Tabletop color fundus camera image: 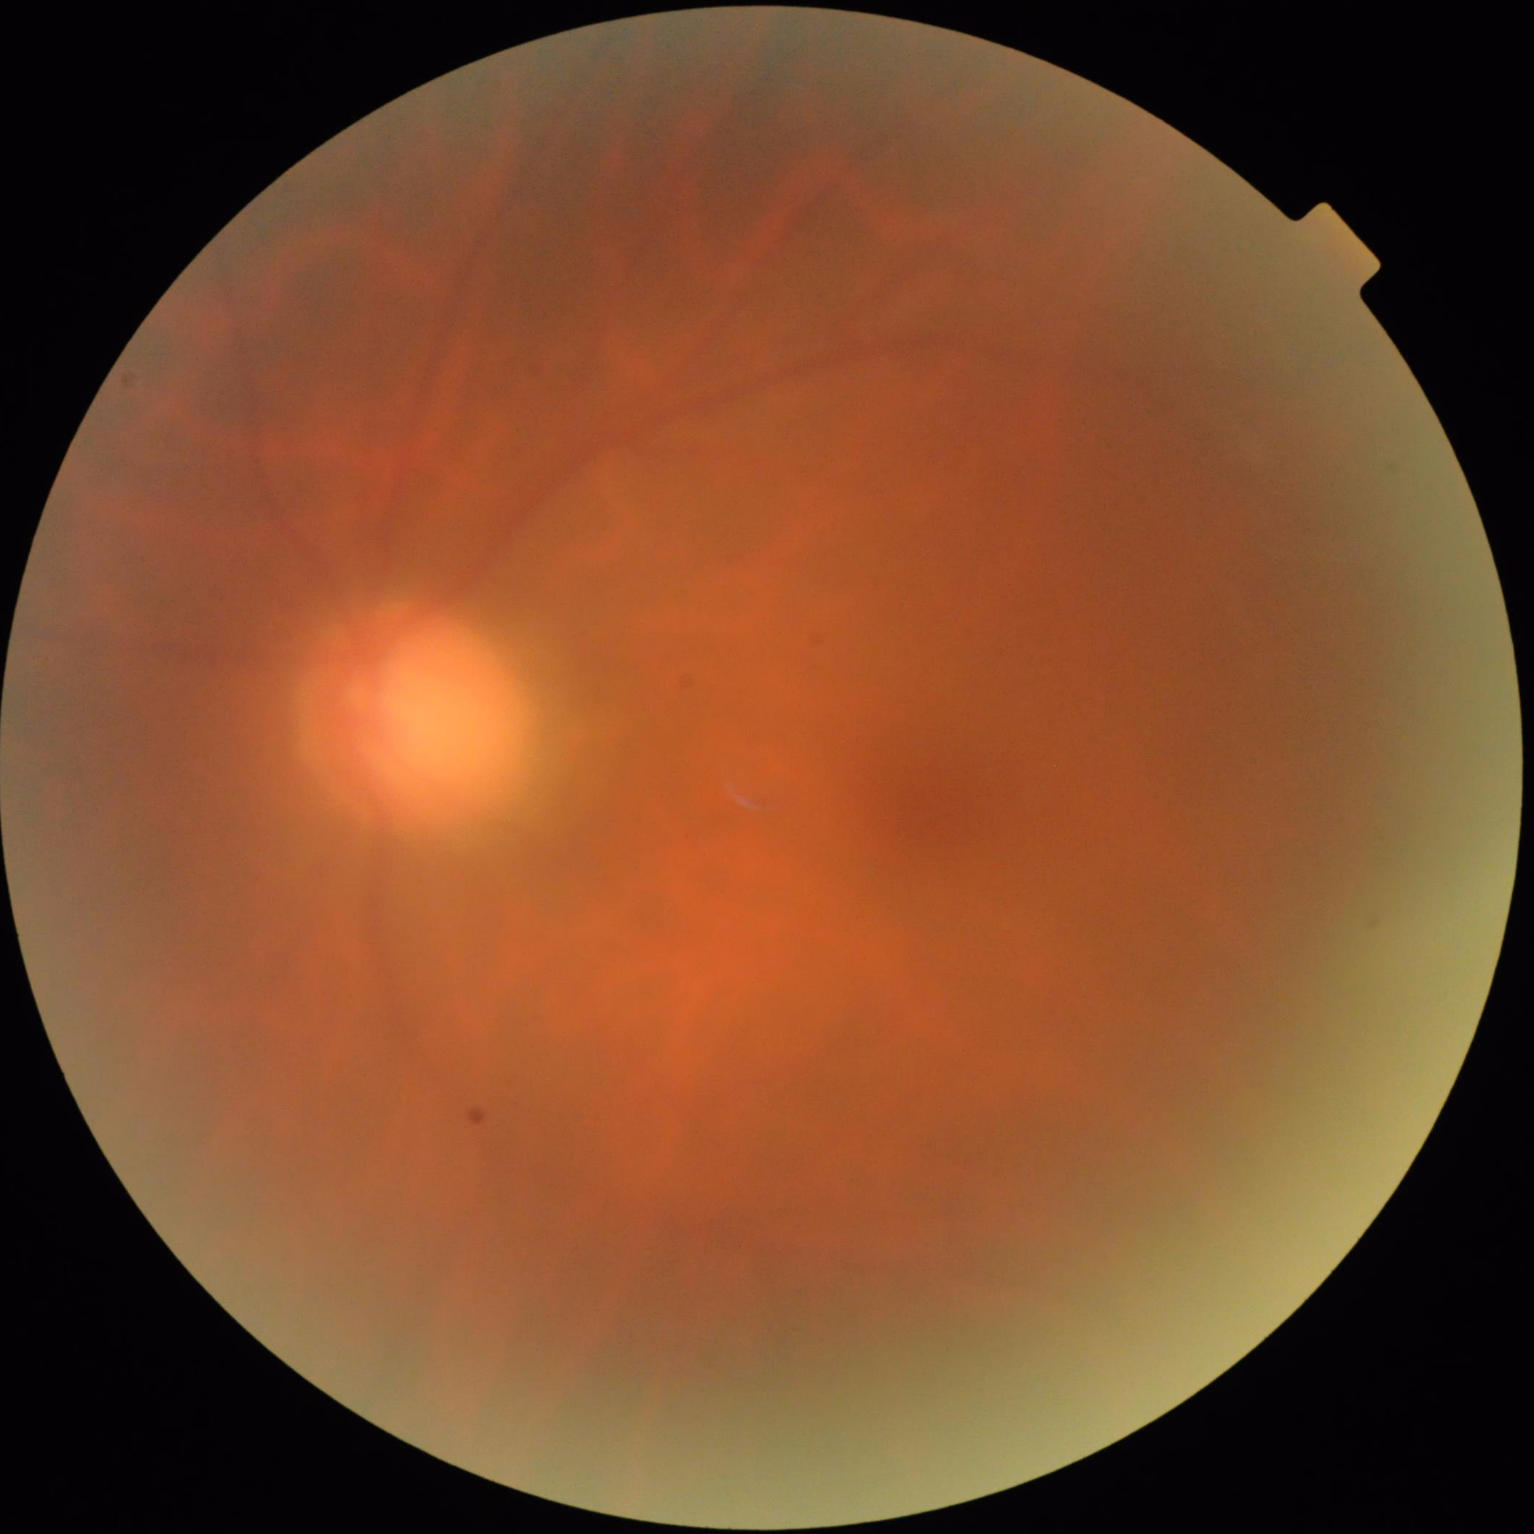 Out of focus; structures are indistinct. Illumination is uneven. Image quality is suboptimal. Contrast is good.